Acquired with a NIDEK AFC-230. 848x848. Modified Davis classification: 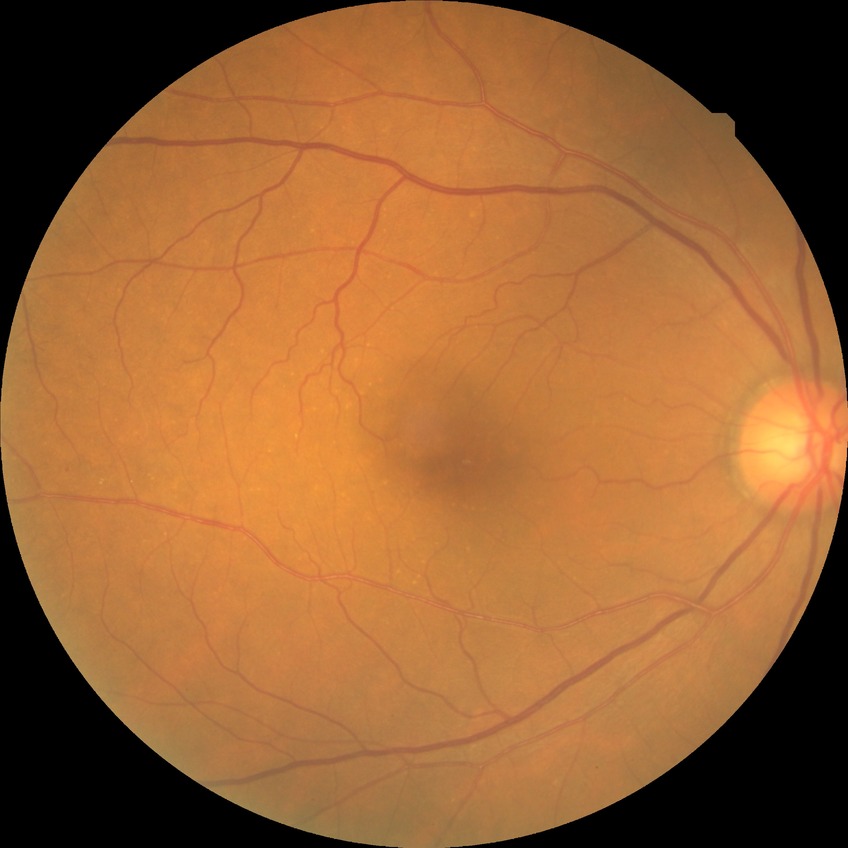
DR class: non-proliferative diabetic retinopathy.
Diabetic retinopathy (DR): SDR (simple diabetic retinopathy).